240x240. Nidek AFC-330: 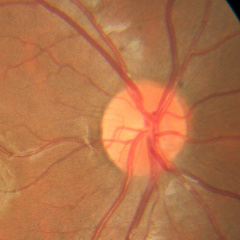 Optic disc photograph demonstrating no glaucomatous findings.